Non-mydriatic fundus camera; 240x240; color fundus photograph:
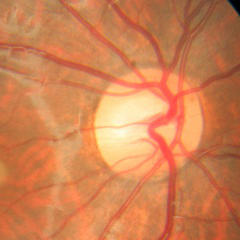 No evidence of glaucoma.